Wide-field contact fundus photograph of an infant
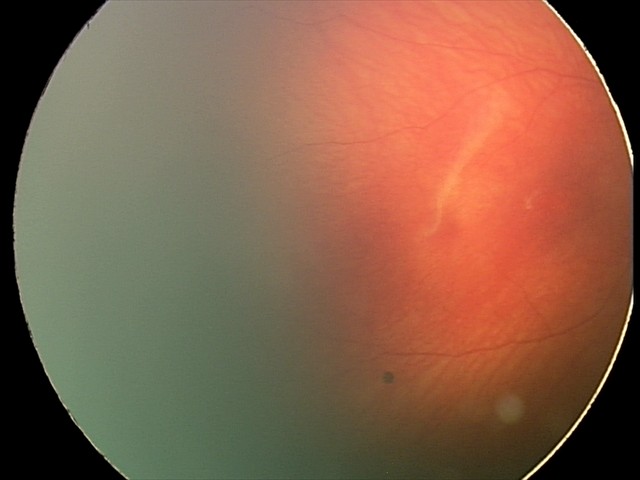
Q: What is the screening diagnosis?
A: physiological retinal finding